Color fundus photograph — 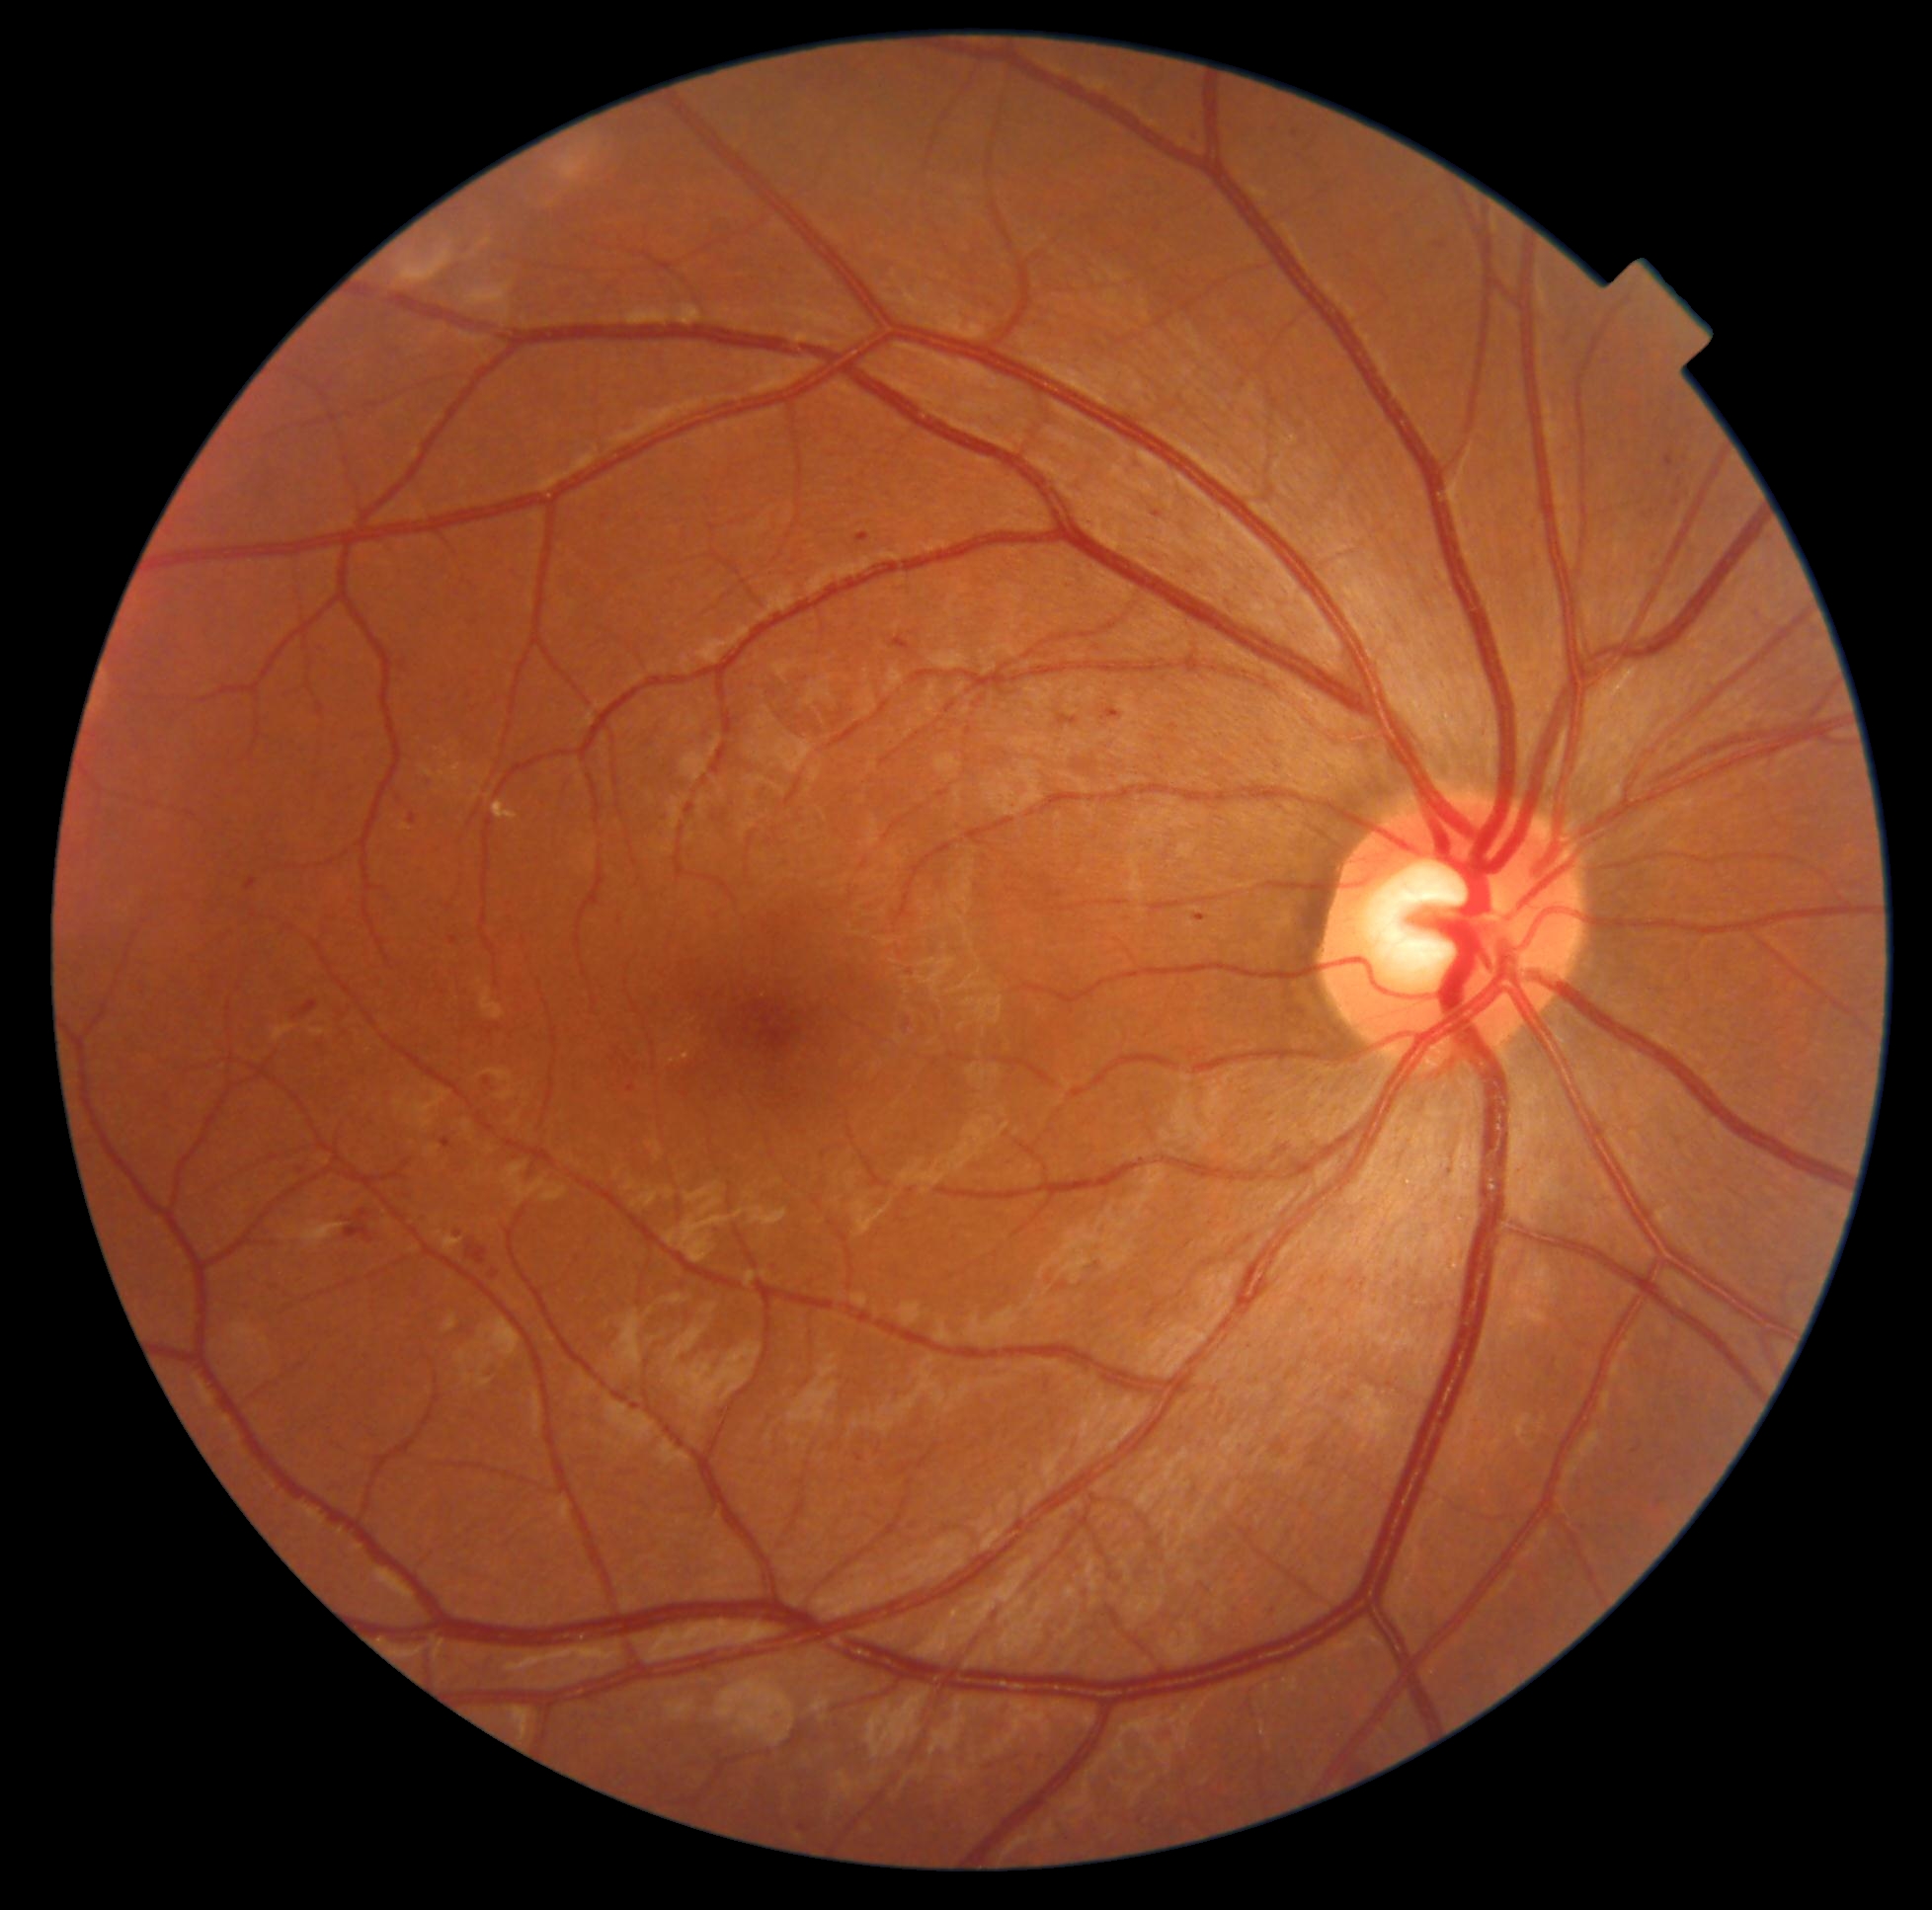 Retinopathy grade is 2/4
A subset of detected lesions:
microaneurysms (subset): rect(857, 533, 870, 542), rect(855, 1455, 864, 1462), rect(1103, 709, 1121, 720), rect(304, 998, 313, 1013), rect(449, 937, 458, 946), rect(493, 1270, 500, 1281), rect(423, 779, 434, 790), rect(1292, 130, 1298, 138), rect(1193, 914, 1208, 919), rect(298, 1167, 307, 1174)
Small microaneurysms approximately at (400; 800), (1141; 462), (459; 1235)